Camera: Clarity RetCam 3 (130° FOV) · 640 by 480 pixels · wide-field contact fundus photograph of an infant:
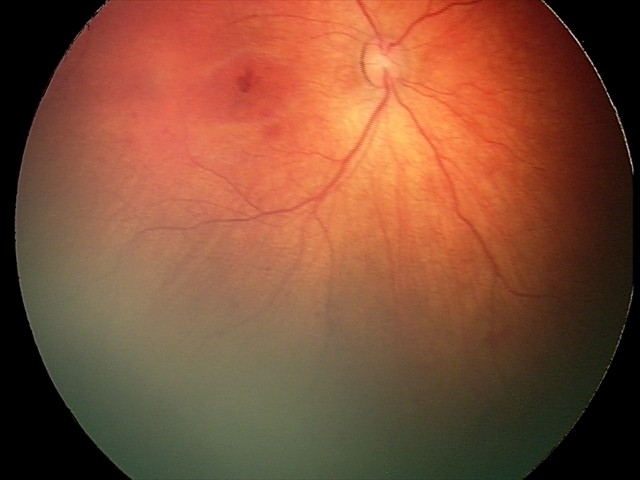

Assessment: retinal hemorrhages.